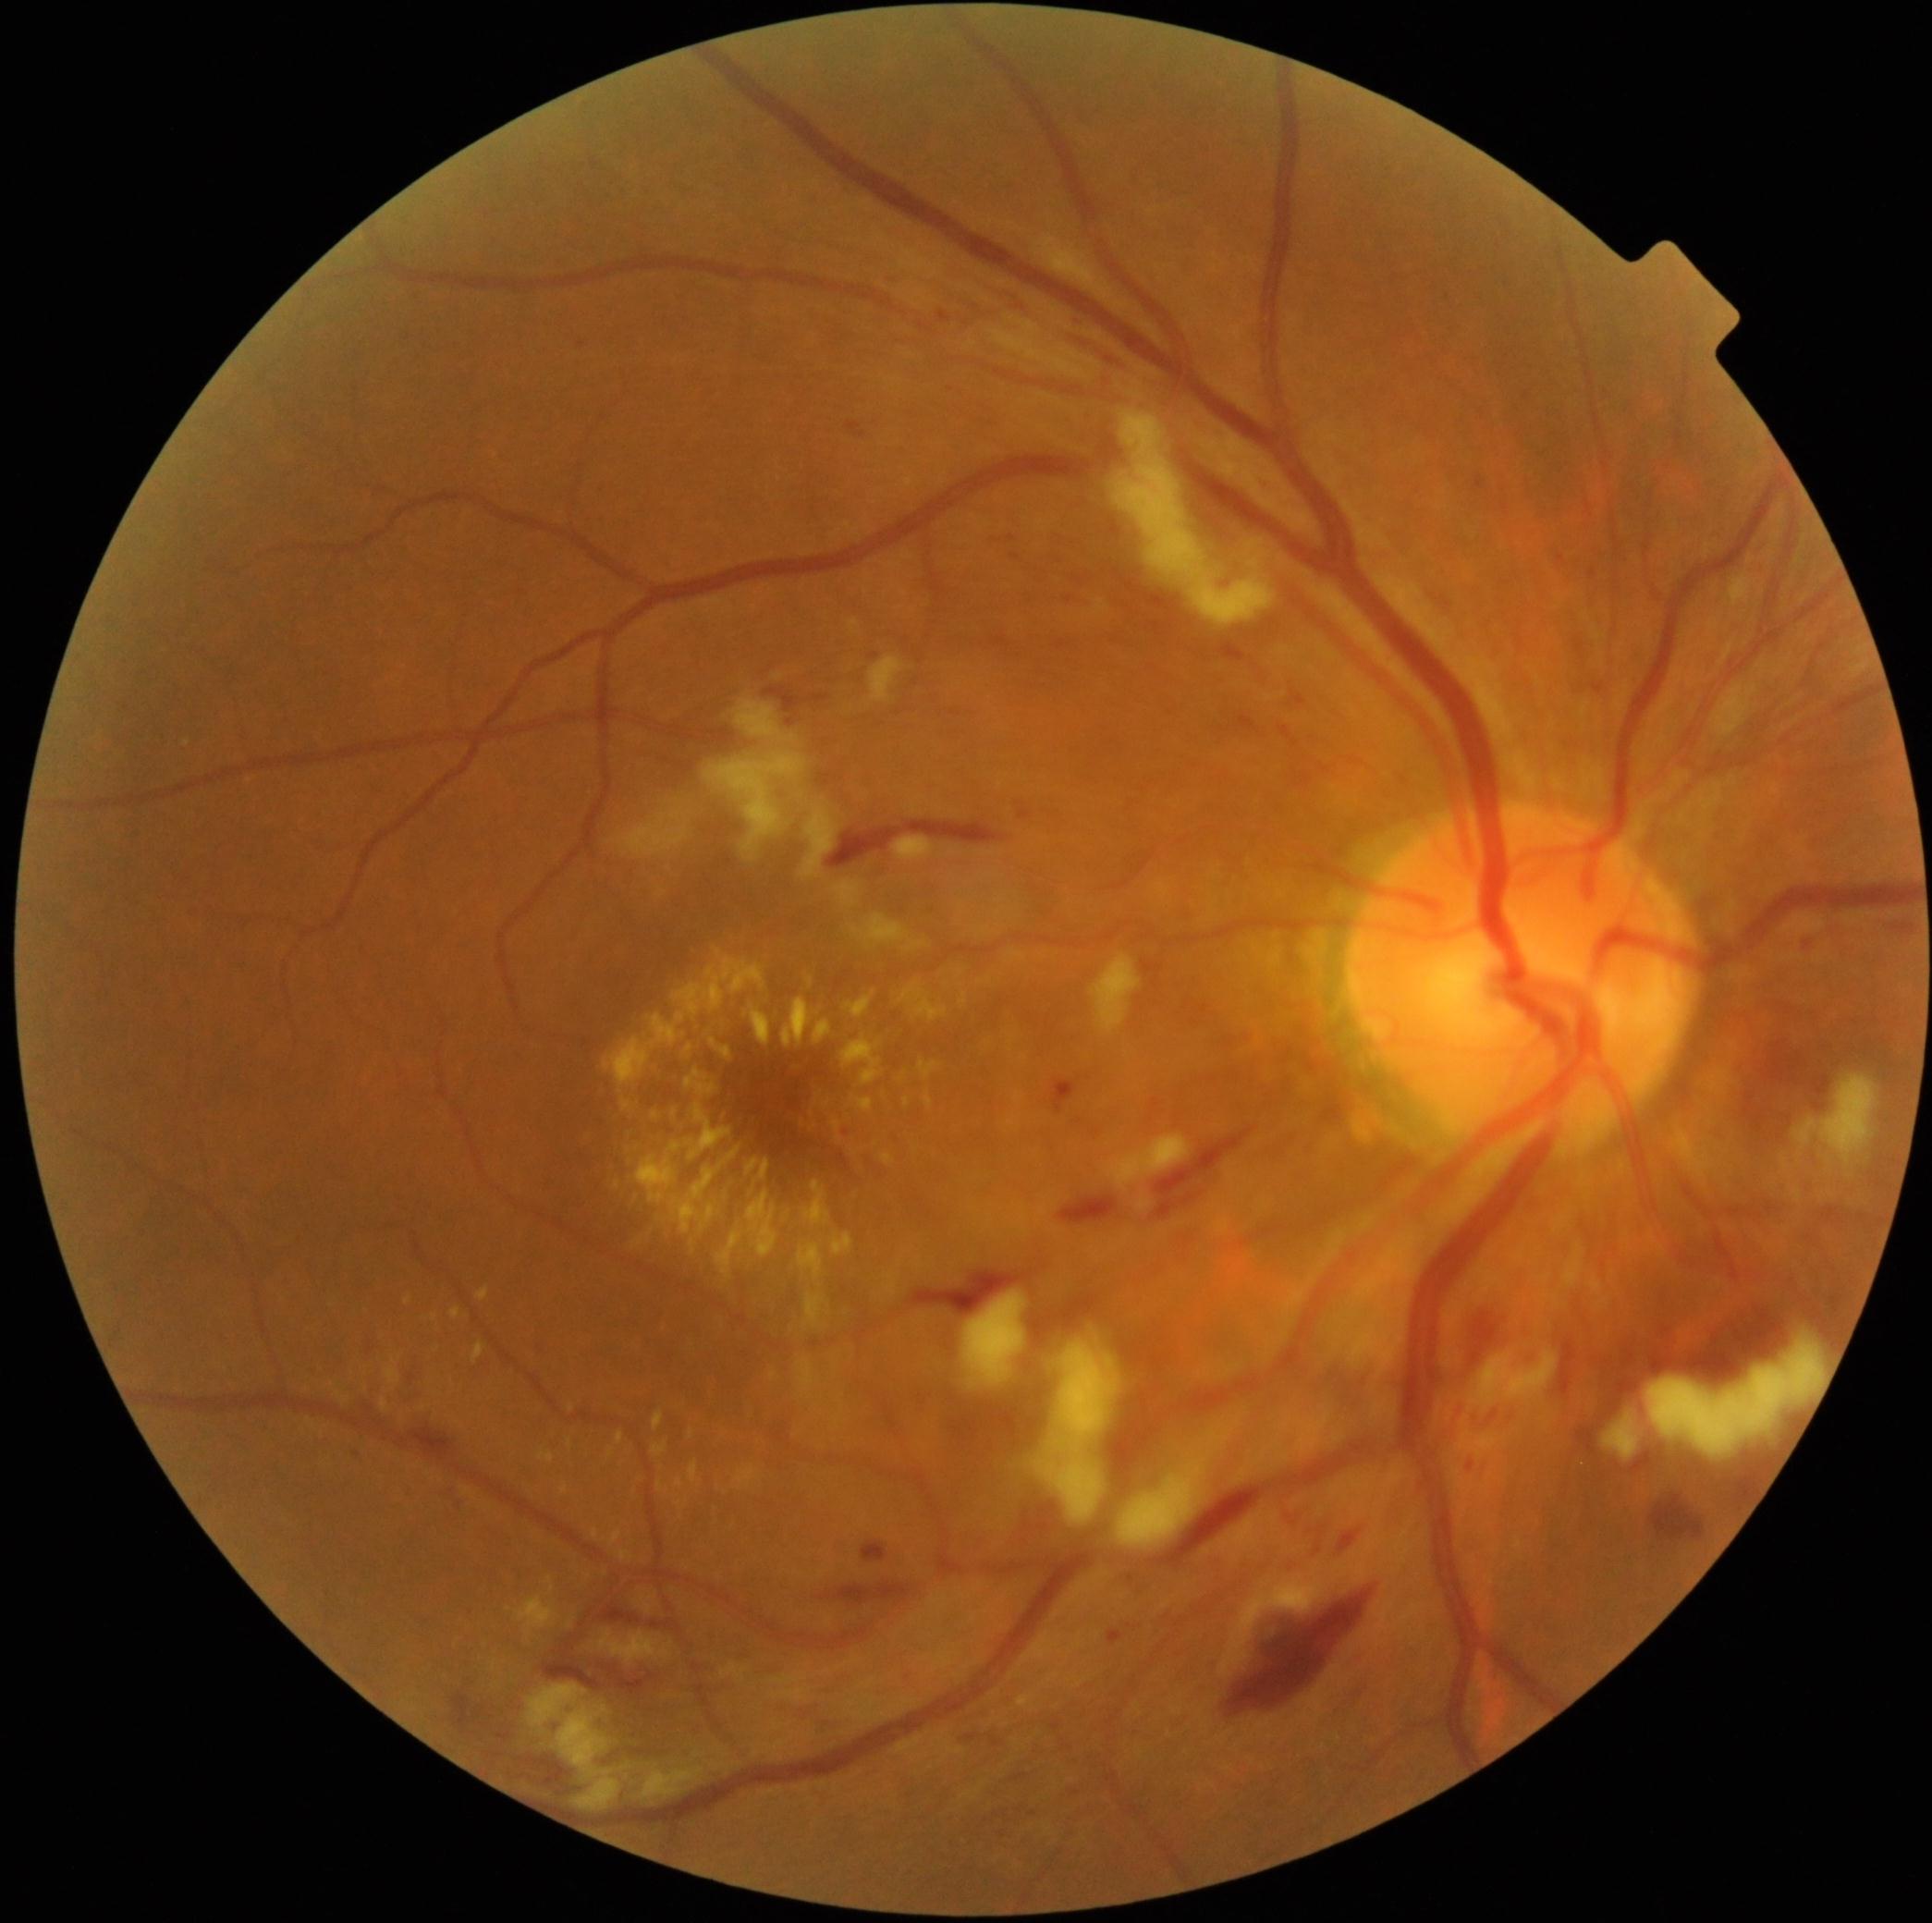 DR severity is severe NPDR (grade 3). SEs are present, including at <bbox>1603, 1413, 1640, 1460</bbox>, <bbox>960, 1292, 1026, 1390</bbox>, <bbox>704, 749, 807, 863</bbox>, <bbox>615, 813, 688, 859</bbox>, <bbox>734, 700, 798, 745</bbox>, <bbox>834, 882, 860, 908</bbox>, <bbox>1035, 1336, 1121, 1523</bbox>, <bbox>1105, 1134, 1191, 1188</bbox>, <bbox>1112, 409, 1277, 628</bbox>, <bbox>527, 1684, 637, 1813</bbox>, <bbox>641, 1764, 706, 1800</bbox>. MAs are present, including at <bbox>938, 312, 951, 325</bbox>, <bbox>1058, 641, 1066, 650</bbox>, <bbox>446, 1482, 458, 1489</bbox>, <bbox>1594, 683, 1605, 694</bbox>, <bbox>1130, 1575, 1135, 1583</bbox>, <bbox>1051, 1080, 1071, 1100</bbox>, <bbox>889, 270, 897, 277</bbox>. Small MAs approximately at (1012,538), (1808,944), (1561,560), (950,391). EXs are present, including at <bbox>690, 1461, 699, 1482</bbox>, <bbox>717, 1228, 745, 1276</bbox>, <bbox>472, 1343, 485, 1364</bbox>, <bbox>905, 1098, 911, 1108</bbox>, <bbox>925, 1091, 933, 1108</bbox>, <bbox>814, 1020, 834, 1045</bbox>, <bbox>1019, 1695, 1033, 1707</bbox>, <bbox>609, 1448, 615, 1458</bbox>, <bbox>622, 1098, 631, 1109</bbox>, <bbox>686, 1069, 719, 1096</bbox>, <bbox>841, 1035, 882, 1085</bbox>, <bbox>677, 1478, 684, 1488</bbox>, <bbox>604, 958, 766, 1087</bbox>. Small EXs approximately at (597,1533), (494,1666), (675,1113). HEs are present, including at <bbox>811, 694, 830, 704</bbox>, <bbox>1442, 1390, 1462, 1422</bbox>, <bbox>1561, 1341, 1576, 1394</bbox>, <bbox>544, 1661, 602, 1689</bbox>, <bbox>1285, 1508, 1309, 1525</bbox>, <bbox>604, 1607, 679, 1635</bbox>, <bbox>1223, 1583, 1376, 1721</bbox>, <bbox>1576, 1427, 1597, 1453</bbox>, <bbox>1475, 476, 1485, 491</bbox>, <bbox>847, 422, 865, 438</bbox>, <bbox>1278, 727, 1300, 747</bbox>, <bbox>828, 822, 1008, 868</bbox>, <bbox>787, 719, 794, 727</bbox>, <bbox>1313, 1506, 1331, 1562</bbox>, <bbox>1466, 1289, 1507, 1374</bbox>.